Ultra-widefield fundus photograph: 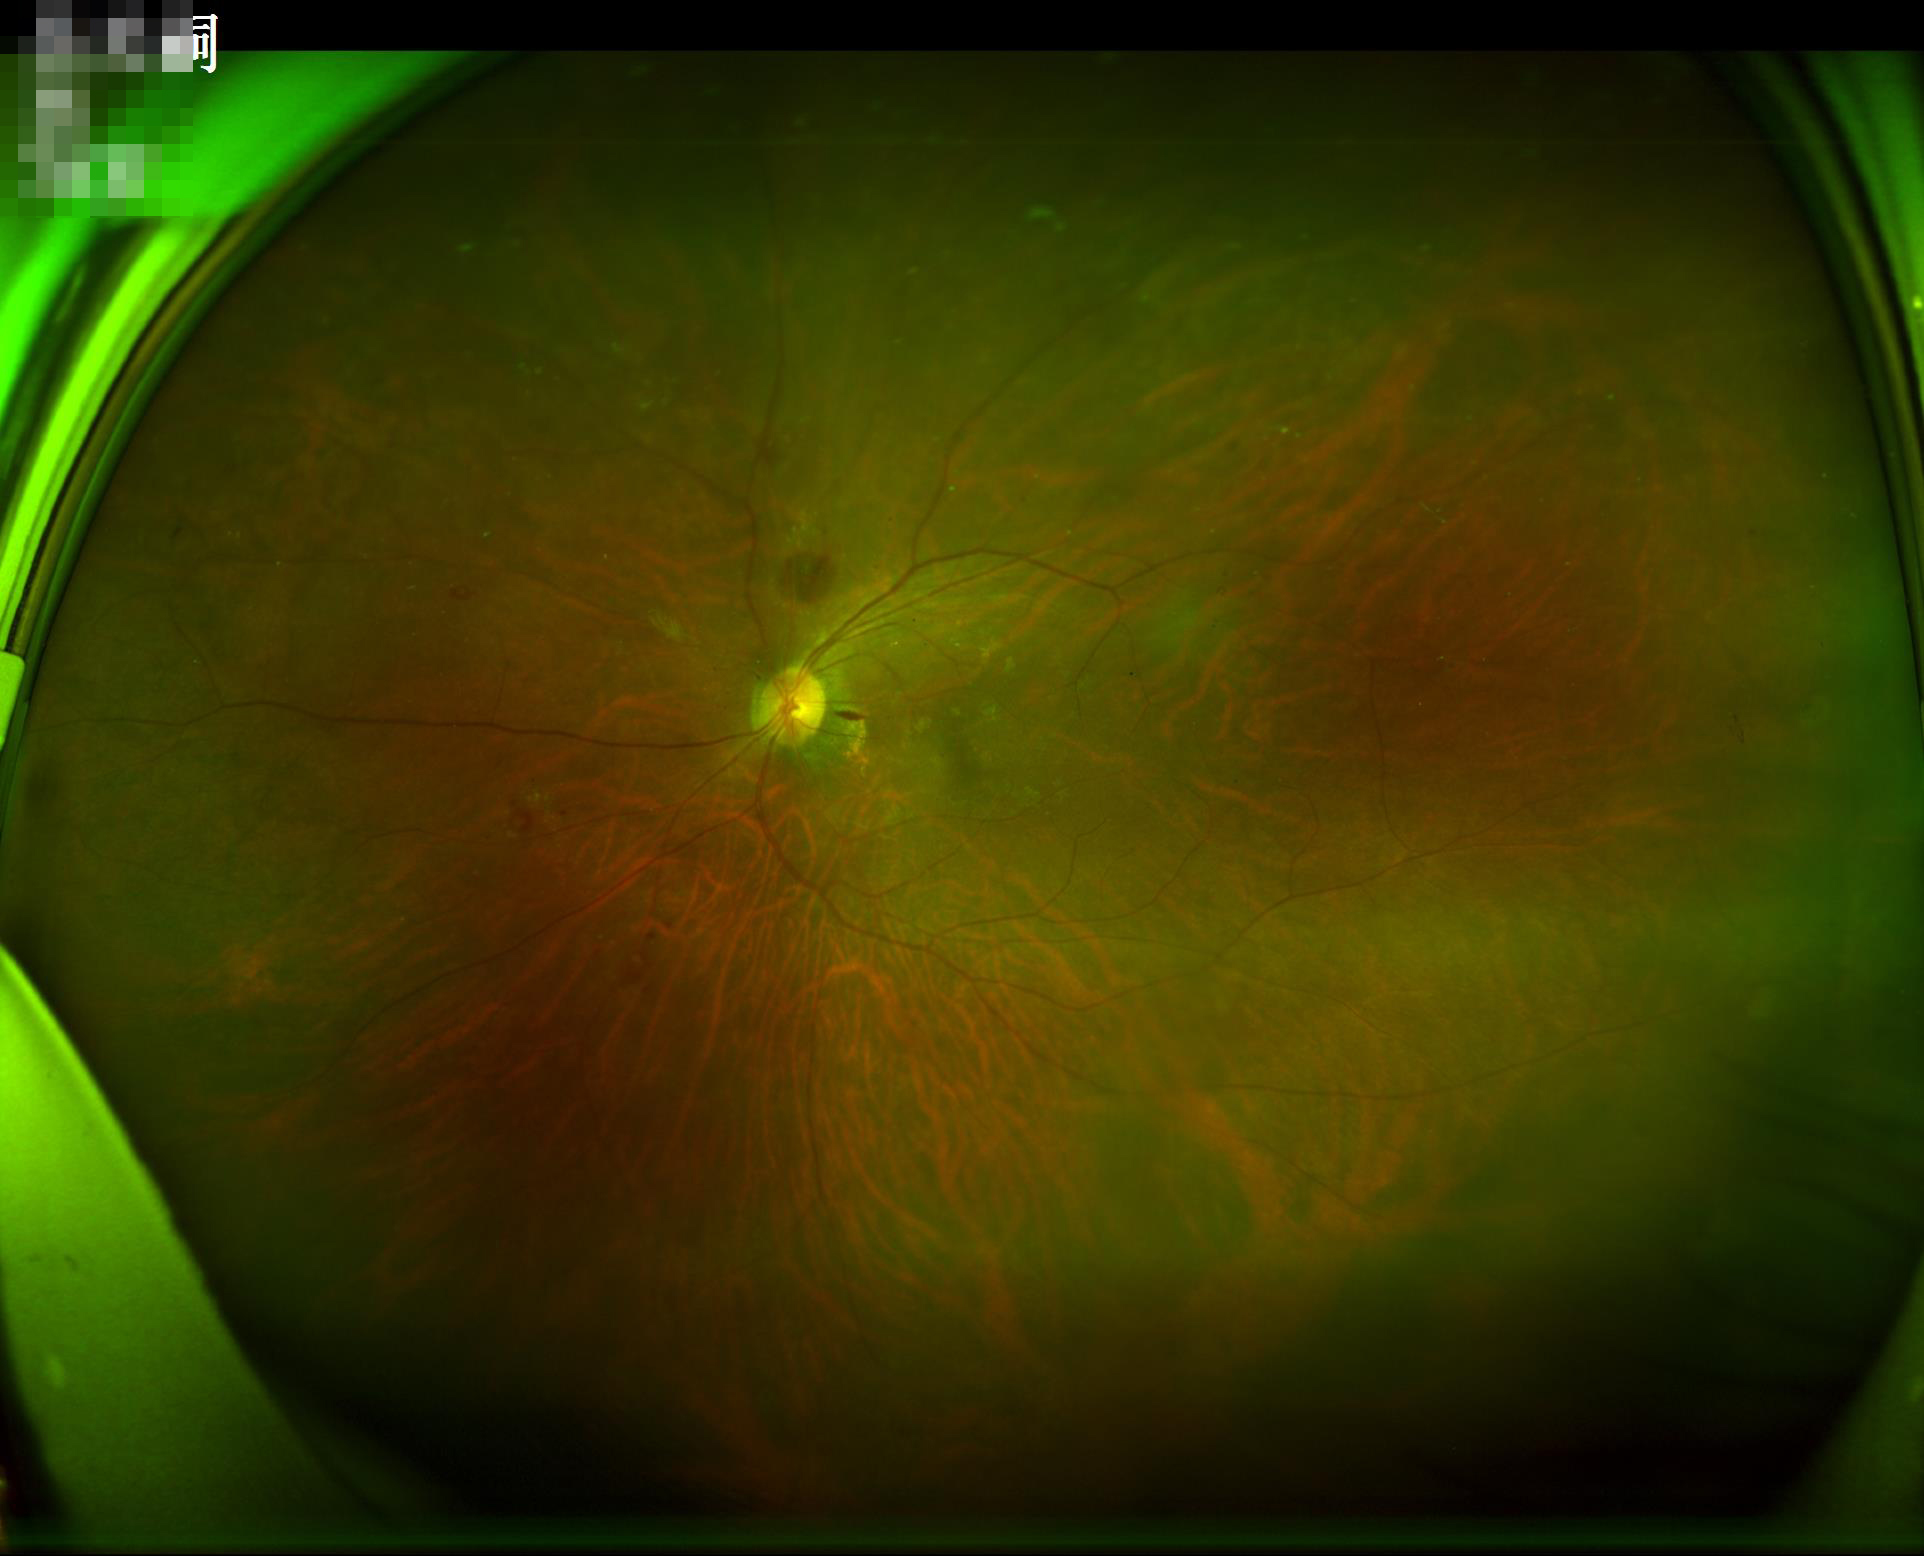 {
  "contrast": "good",
  "overall_quality": "good",
  "illumination": "even",
  "clarity": "sharp"
}